45° field of view; 2352 by 1568 pixels
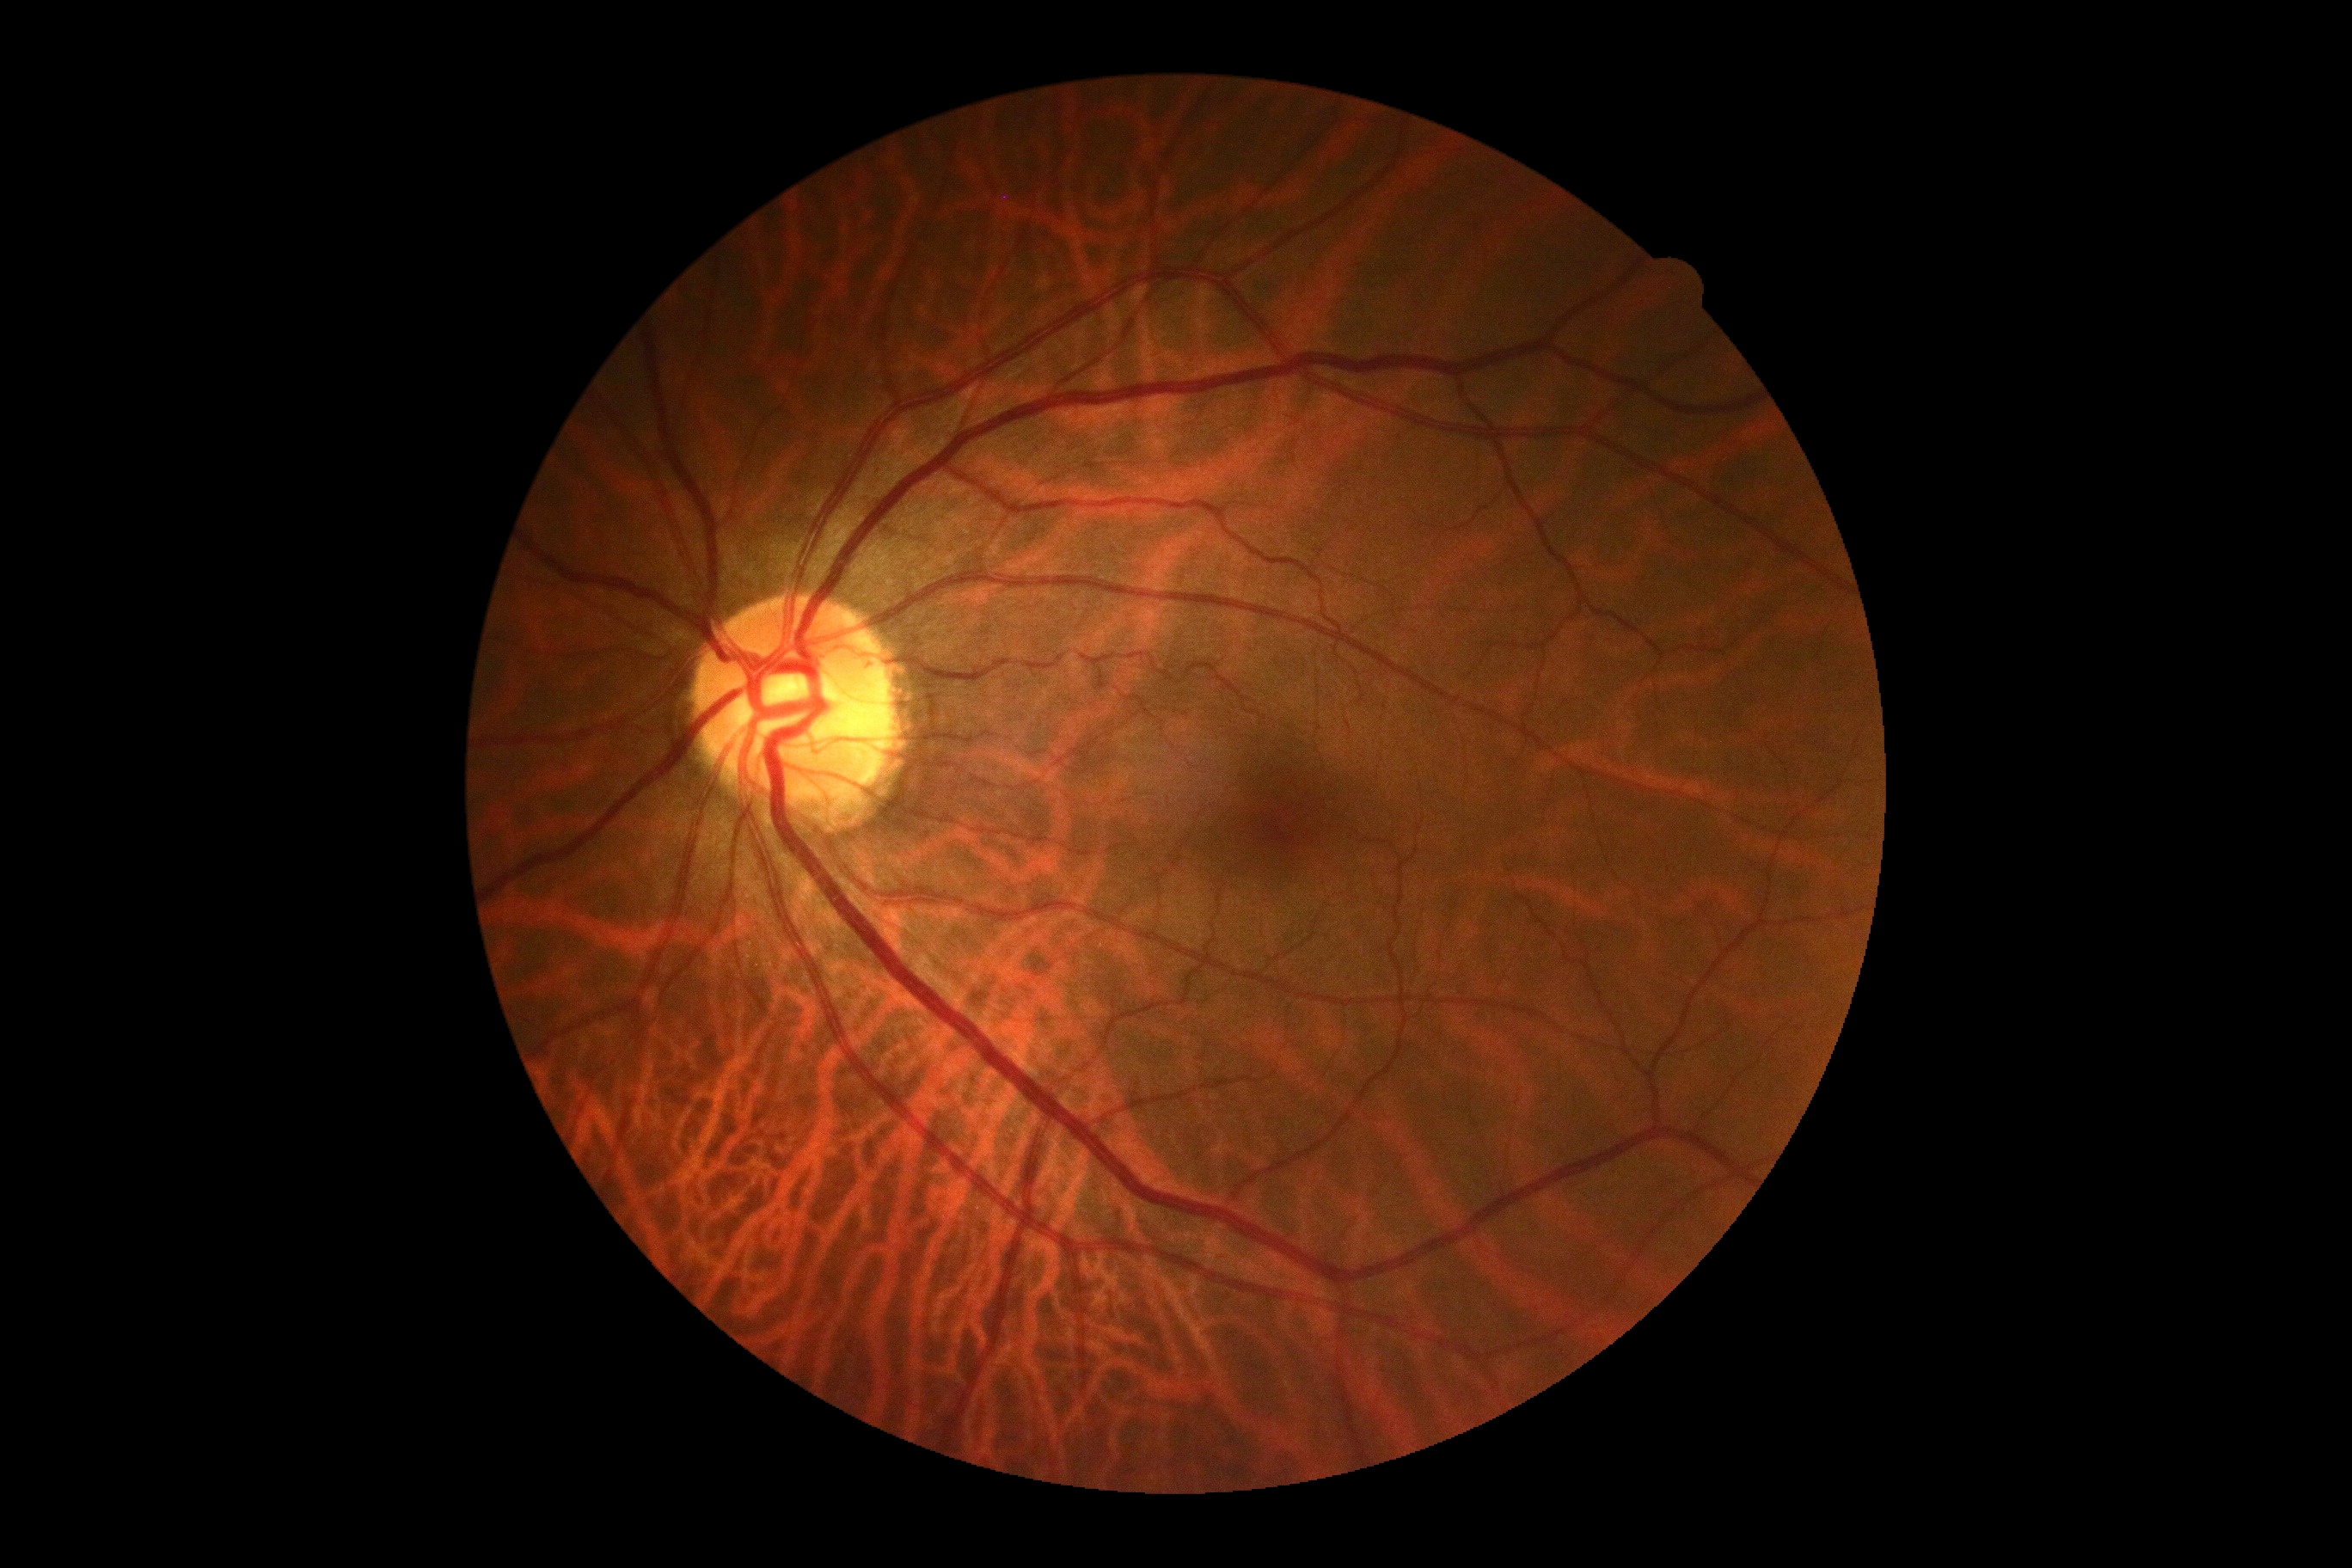 Retinopathy is grade 0.